Camera: Remidio FOP fundus camera · retinal fundus photograph
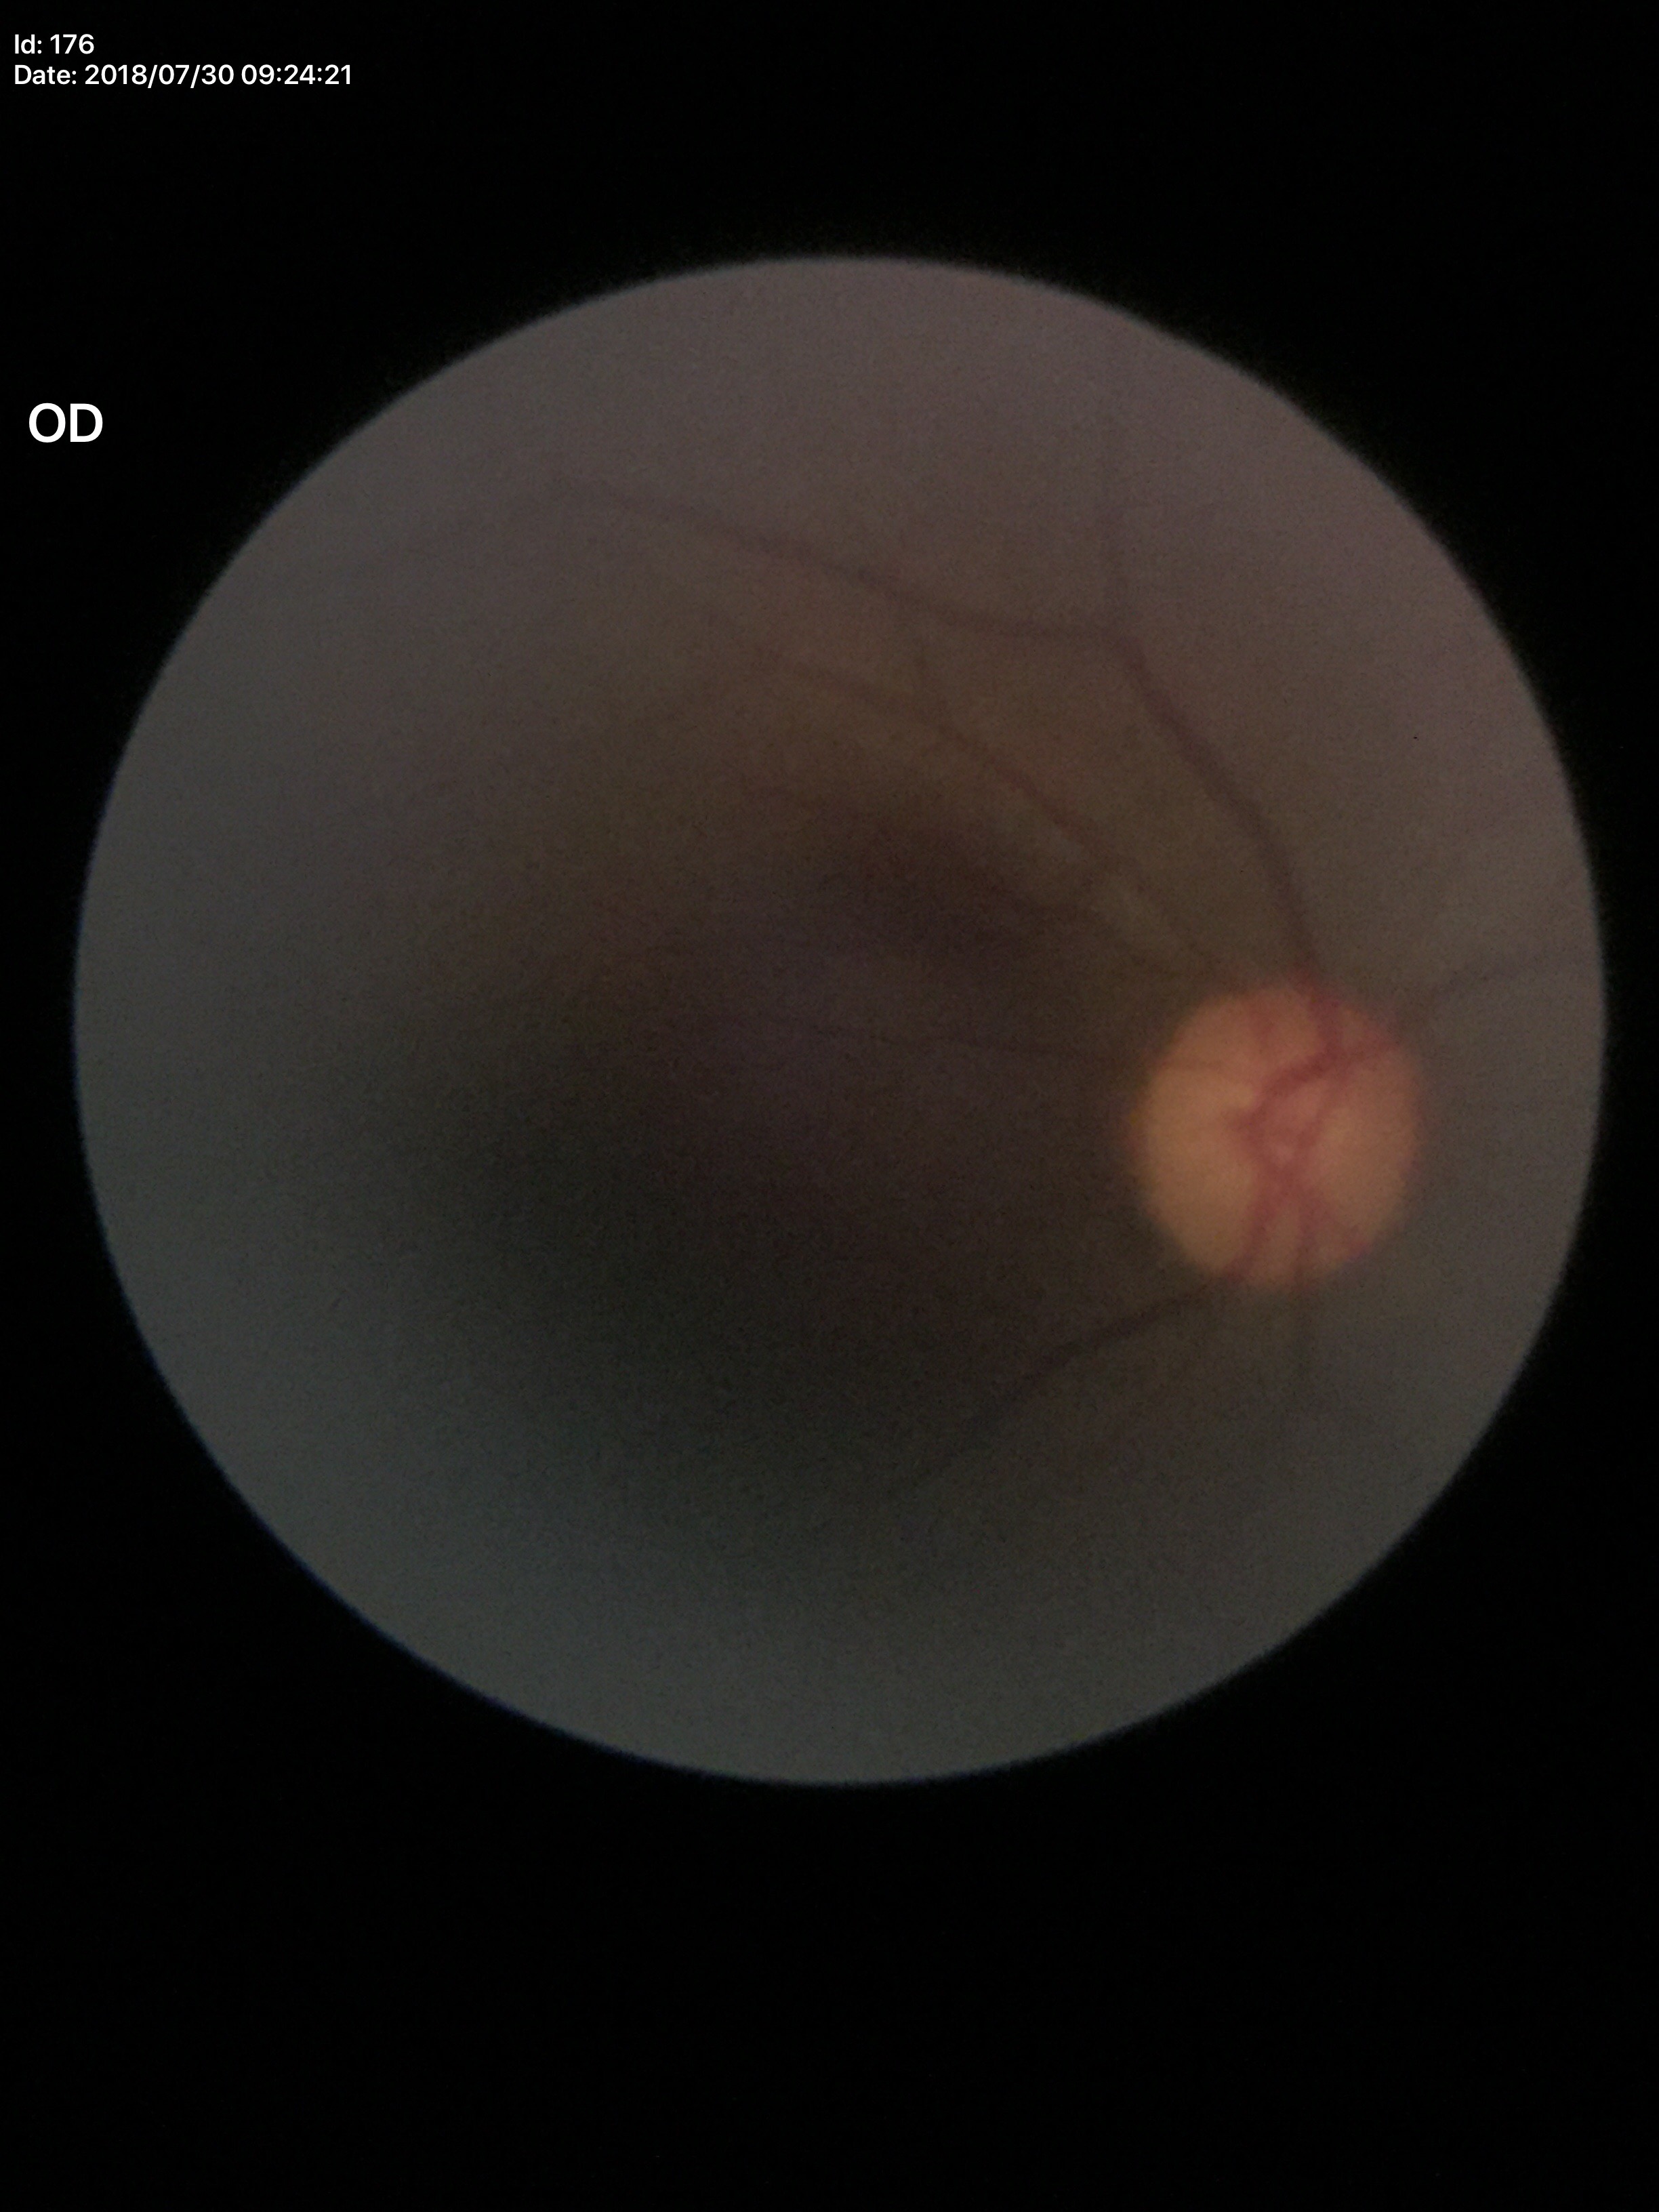

Q: Is there glaucoma suspicion?
A: not suspect
Q: What is the VCDR?
A: 0.45